45° FOV.
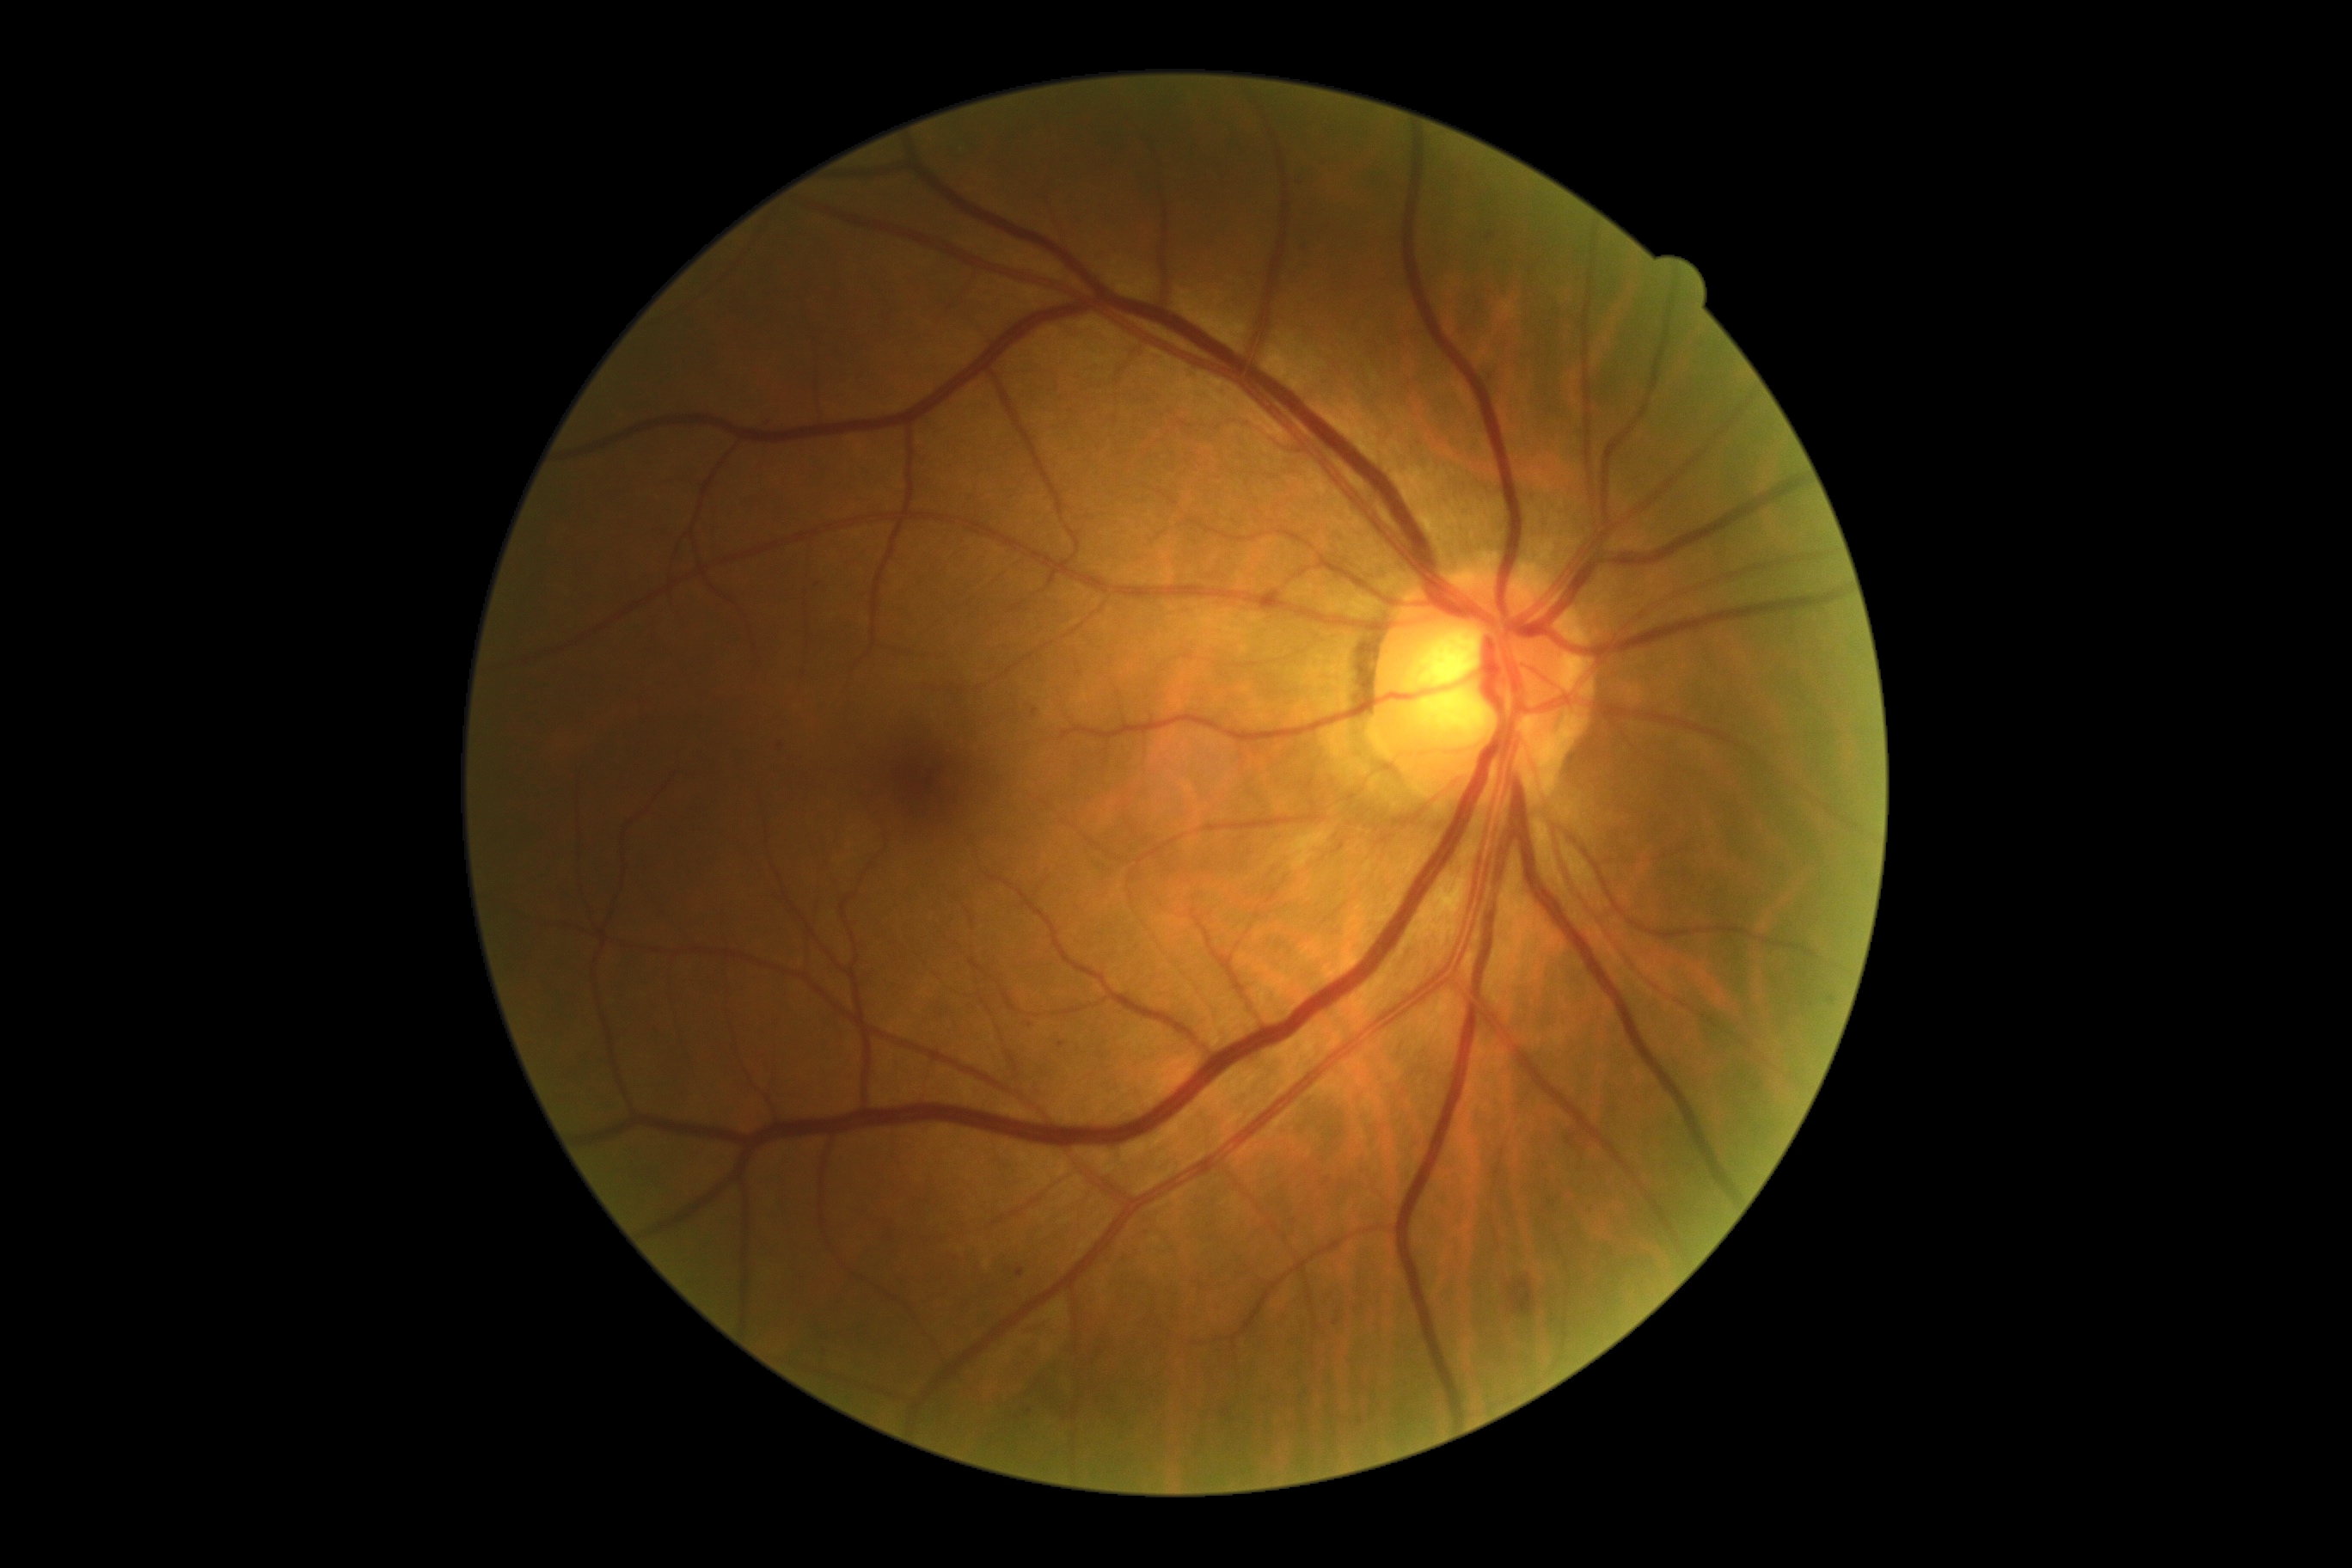
• DR stage — moderate non-proliferative diabetic retinopathy (grade 2)
• DR class — non-proliferative diabetic retinopathy